1240x1240px · Phoenix ICON wide-field infant fundus image · camera: Phoenix ICON (100° FOV)
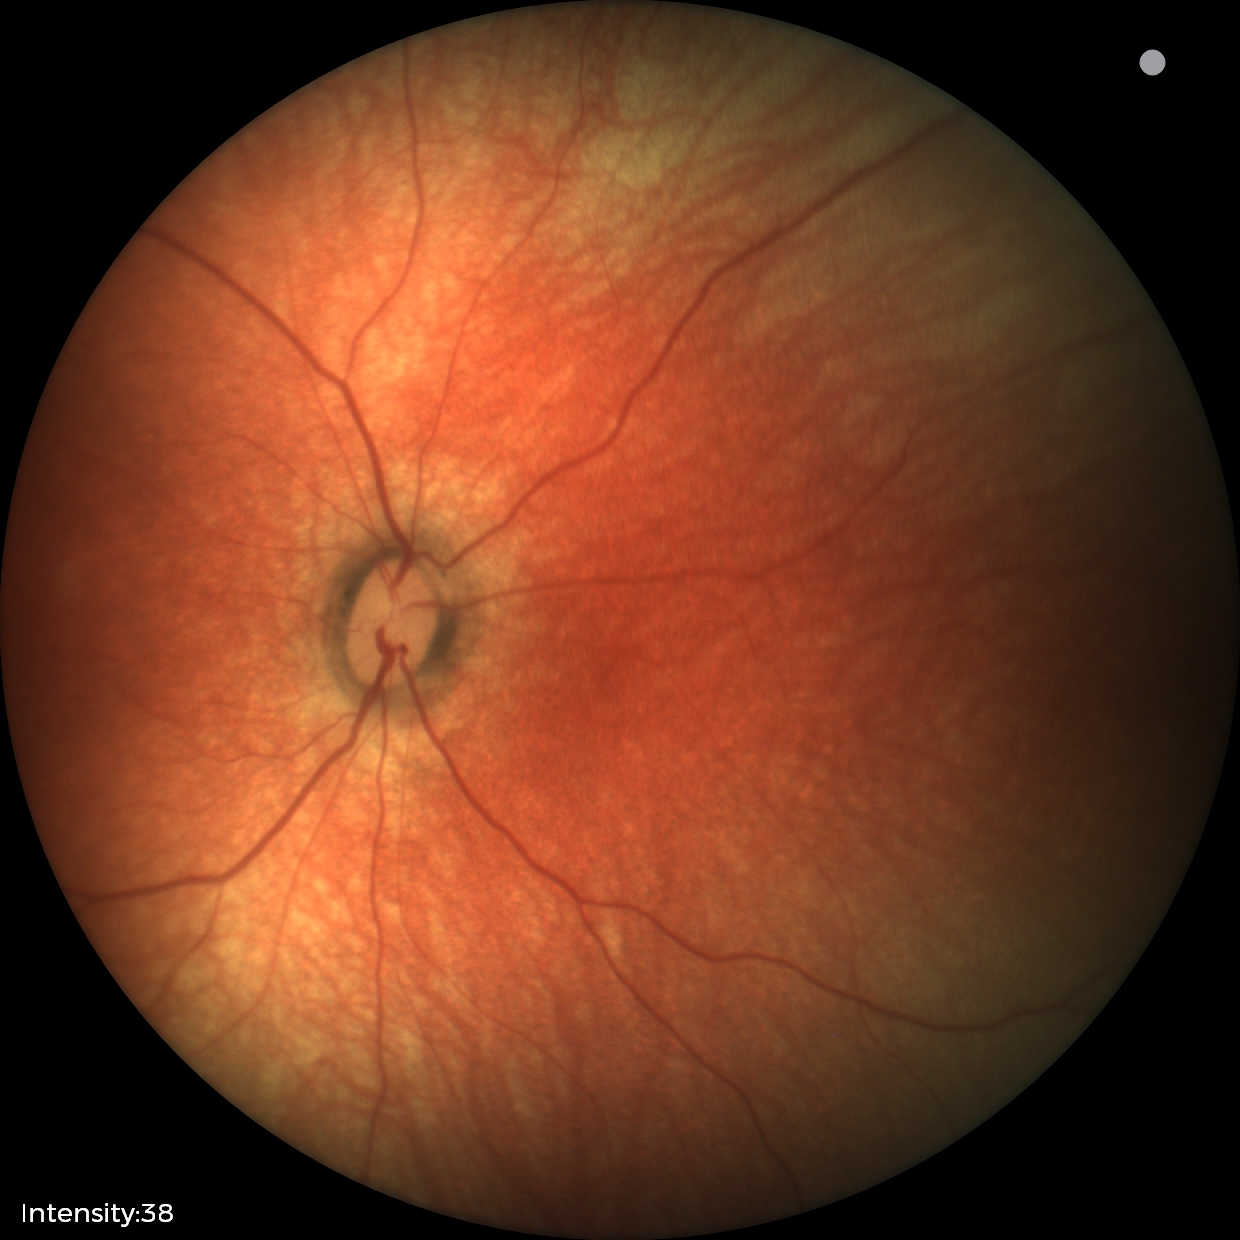
Examination with physiological retinal findings.